Acquired with a NIDEK AFC-230 — 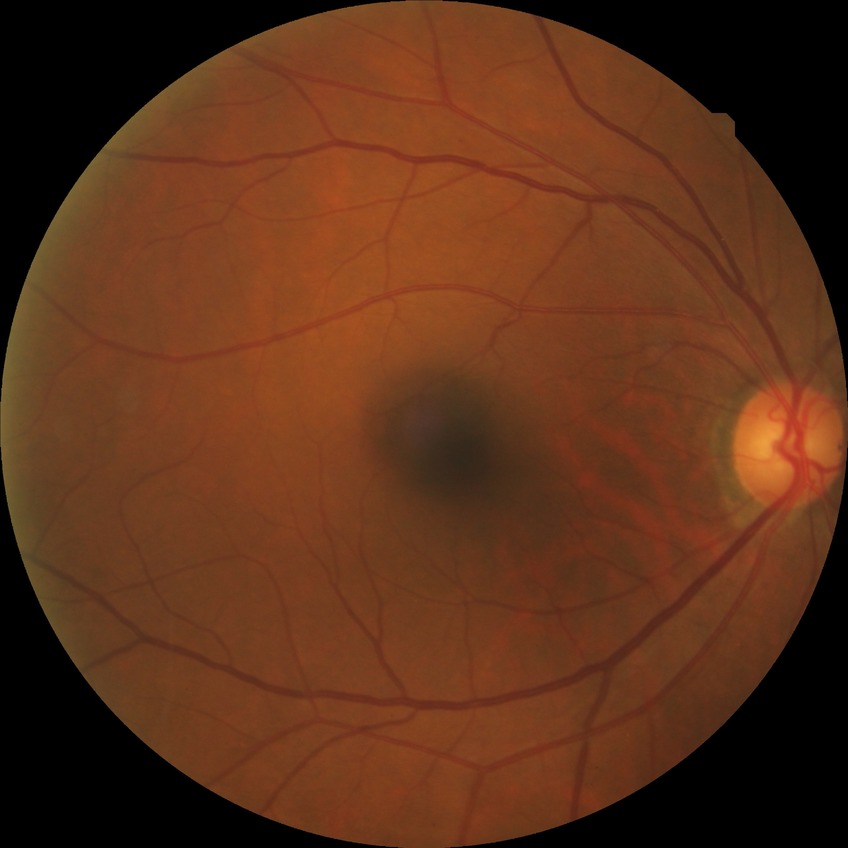 Modified Davis grading is no diabetic retinopathy.